Posterior pole color fundus photograph; acquired with a NIDEK AFC-230:
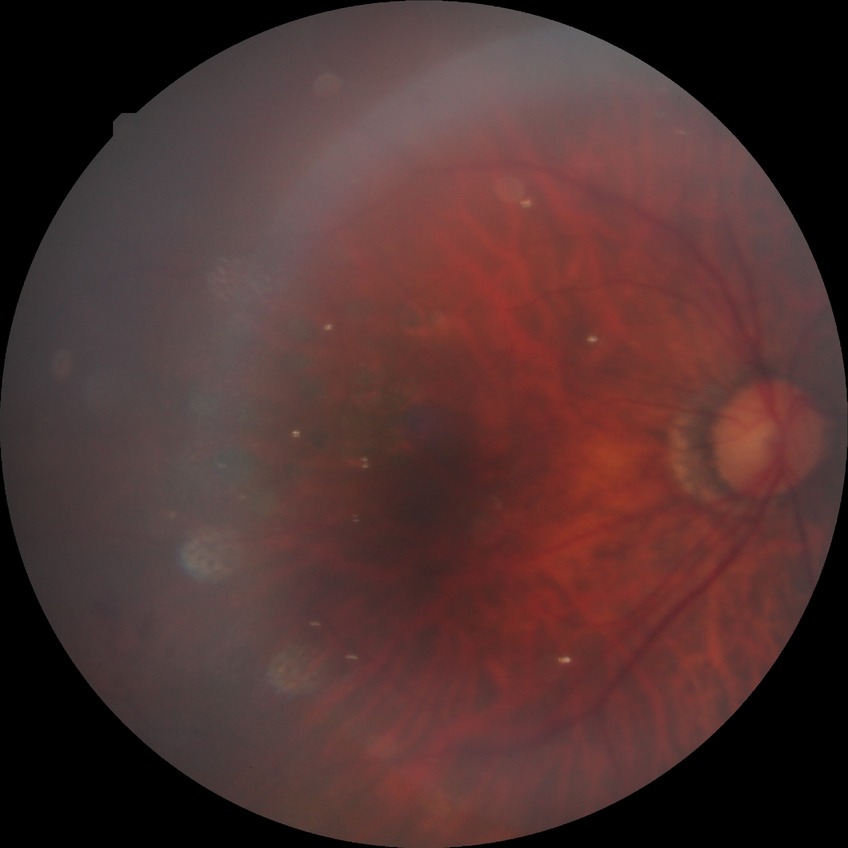 Diabetic retinopathy (DR): proliferative diabetic retinopathy (PDR).